1659x2212, captured on a Remidio Fundus on Phone — 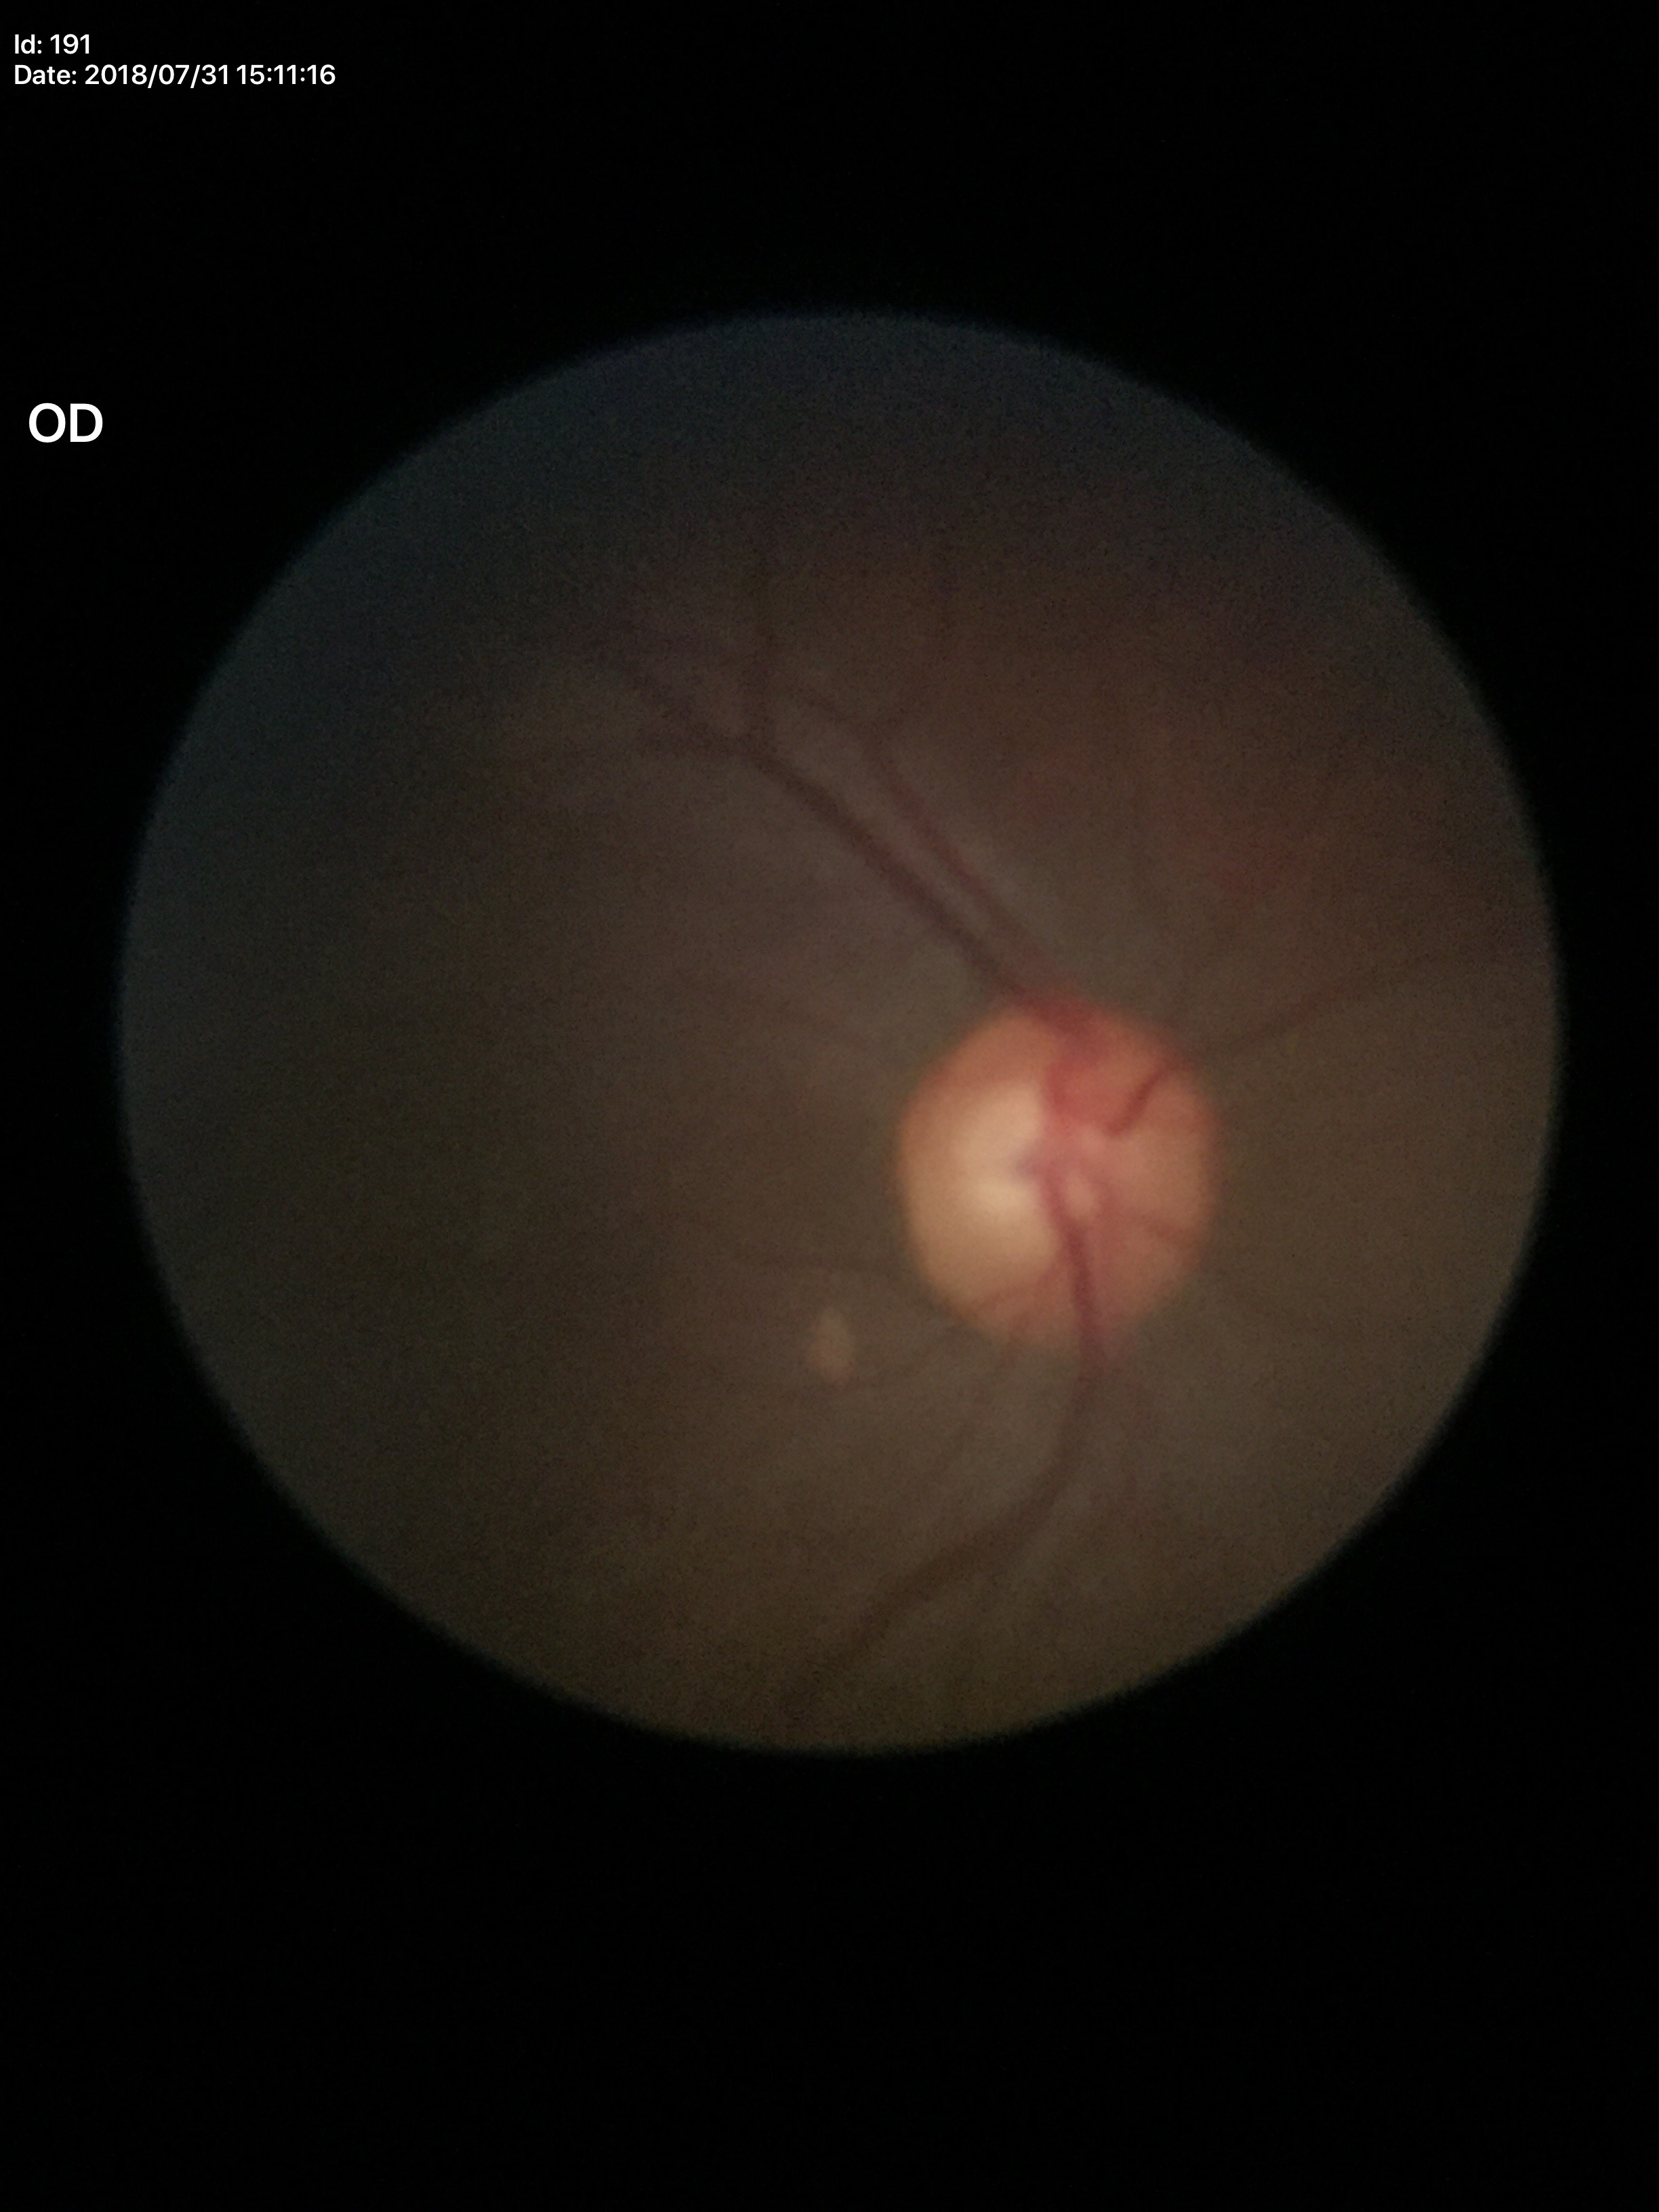

Glaucoma assessment: suspicious findings (3/5 graders called glaucoma suspect)
vertical cup-disc ratio: 0.61